Diabetic retinopathy graded by the modified Davis classification, without pupil dilation — 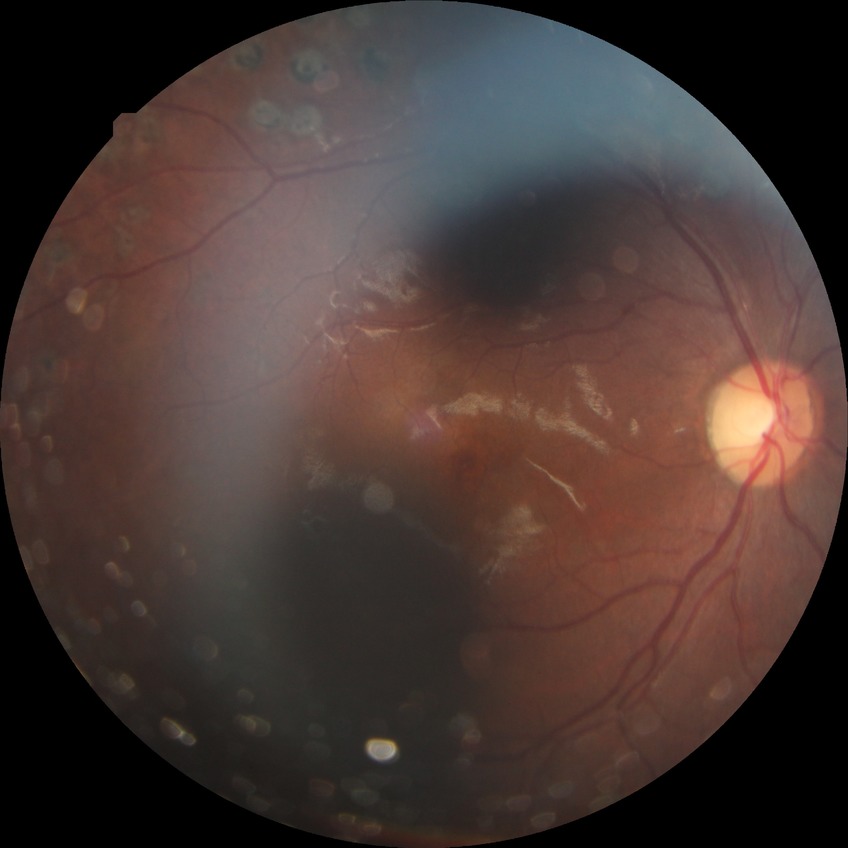
Assessment:
* Davis grading — proliferative diabetic retinopathy